45-degree field of view:
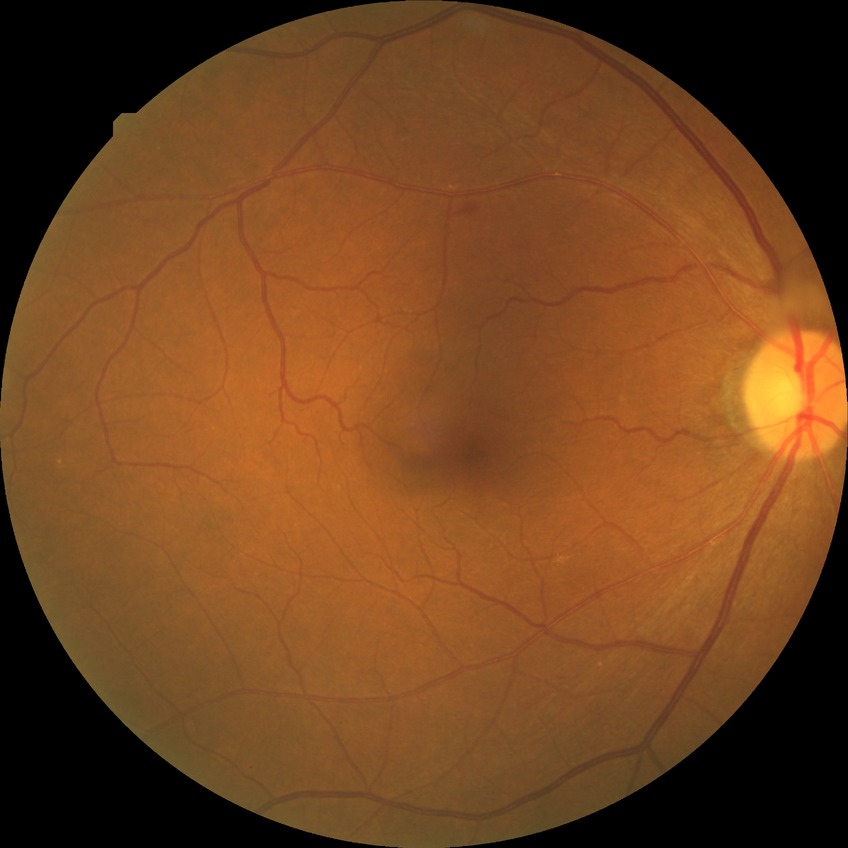

retinopathy stage: simple diabetic retinopathy